NIDEK AFC-230 · 45-degree field of view · nonmydriatic · color fundus photograph: 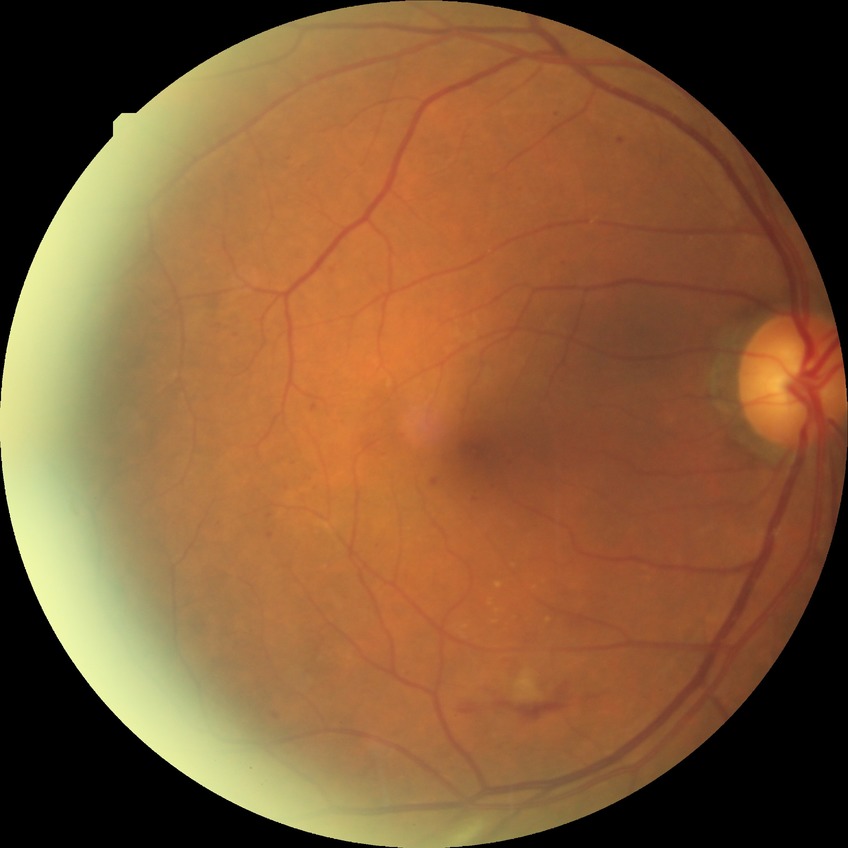 DR severity: PPDR.